Ultra-widefield fundus mosaic — 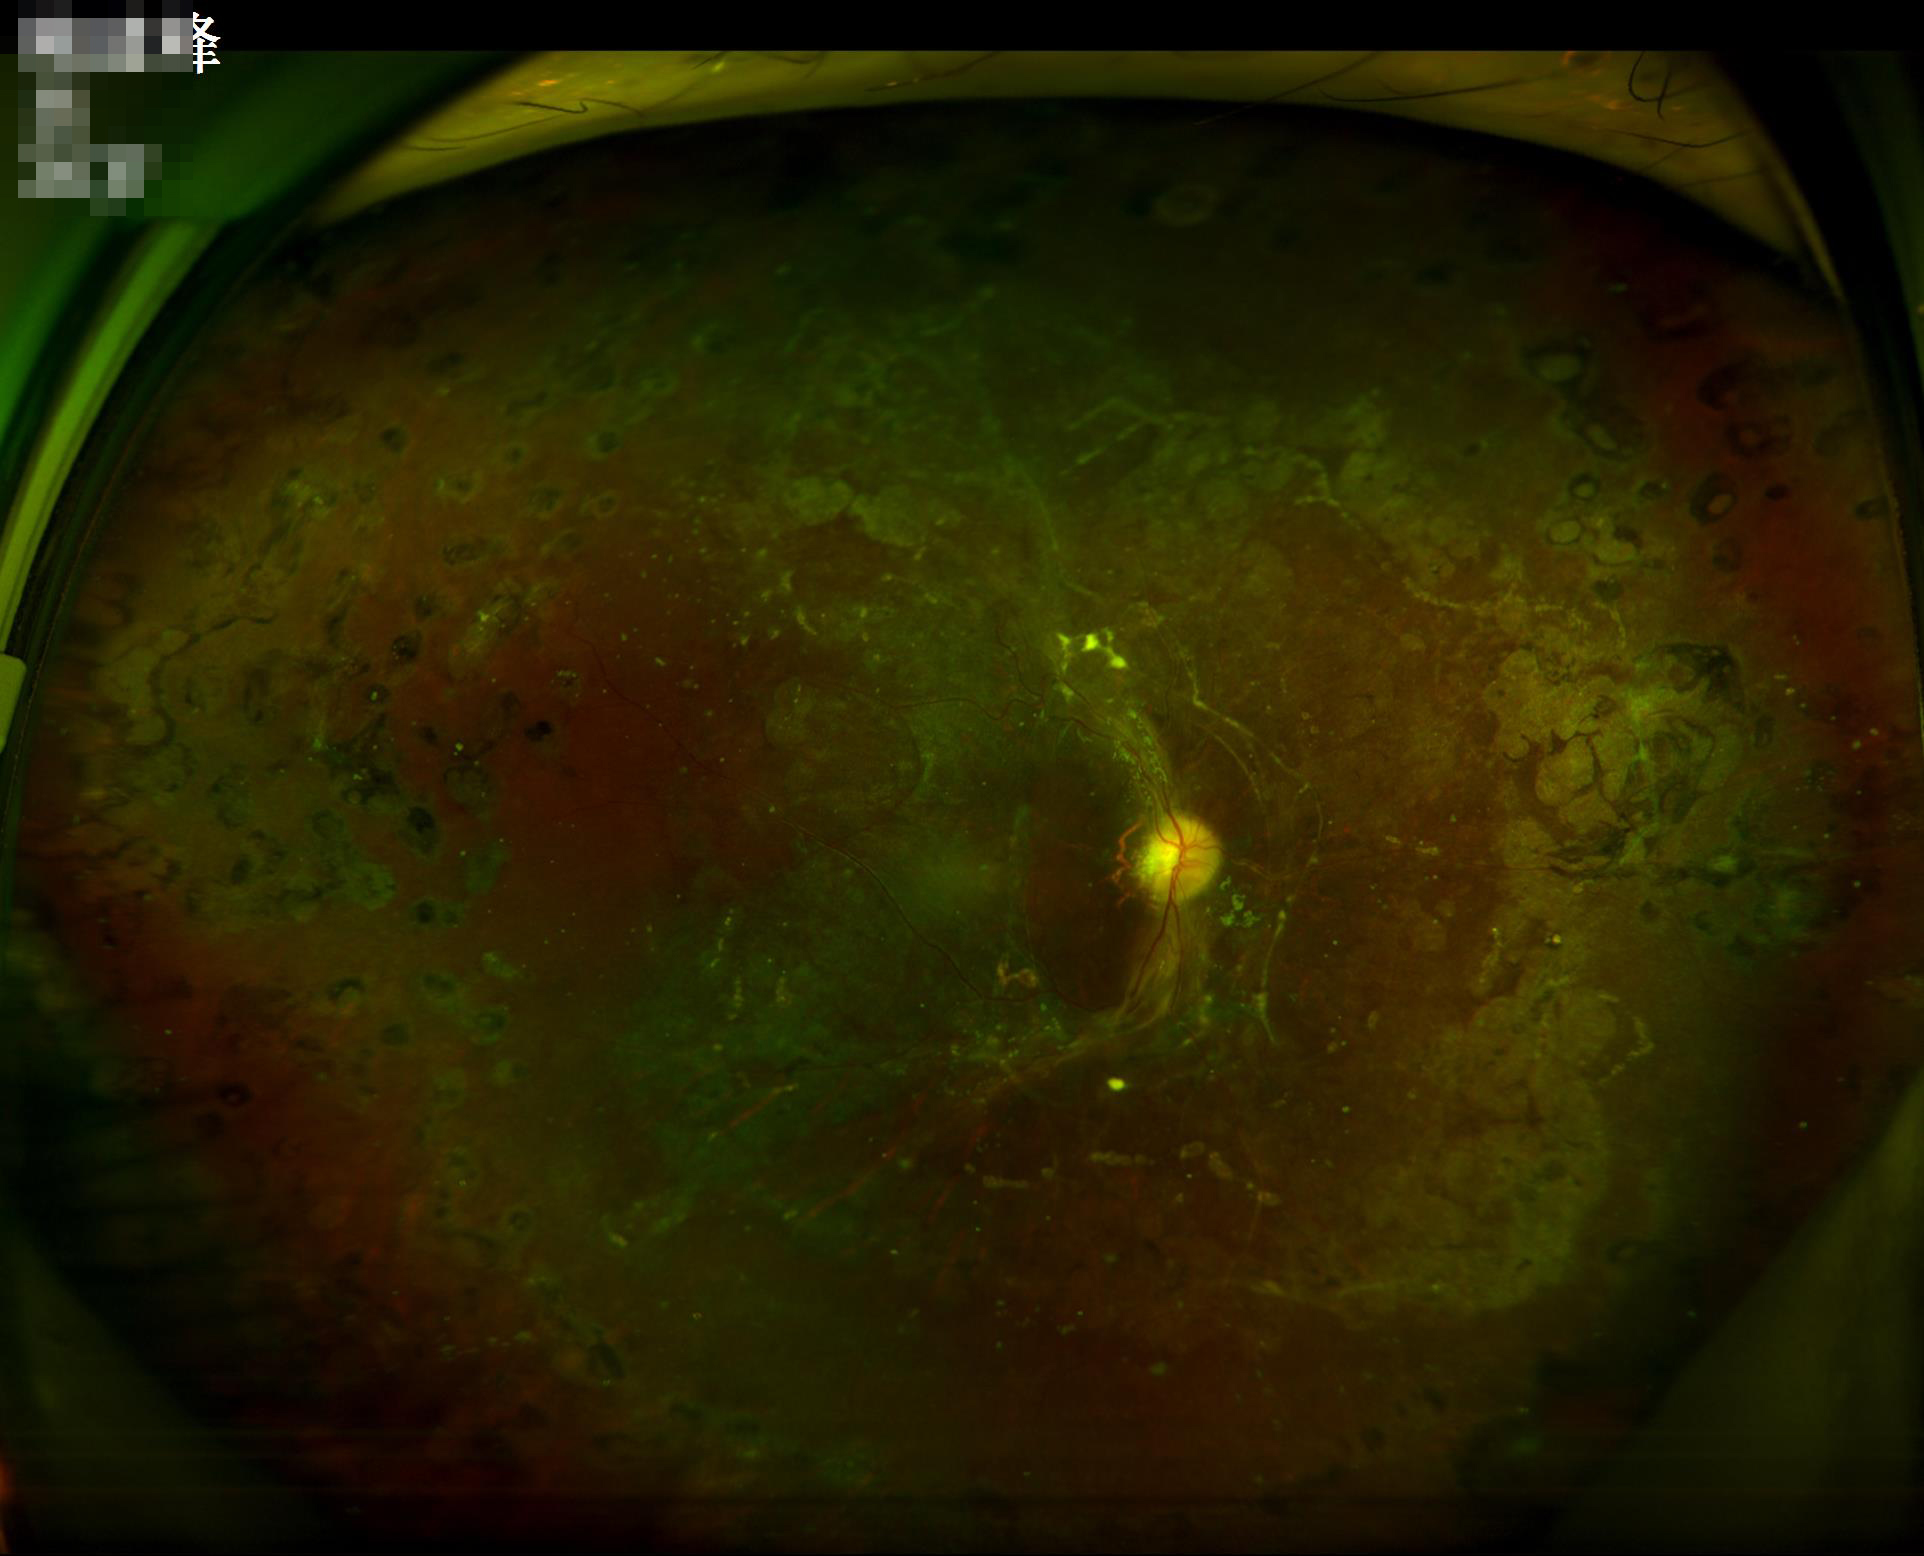 Overall = poor | Illumination/color = uneven | Contrast = poor | Sharpness = blurry.